Modified Davis grading; posterior pole photograph; acquired with a NIDEK AFC-230; nonmydriatic fundus photograph: 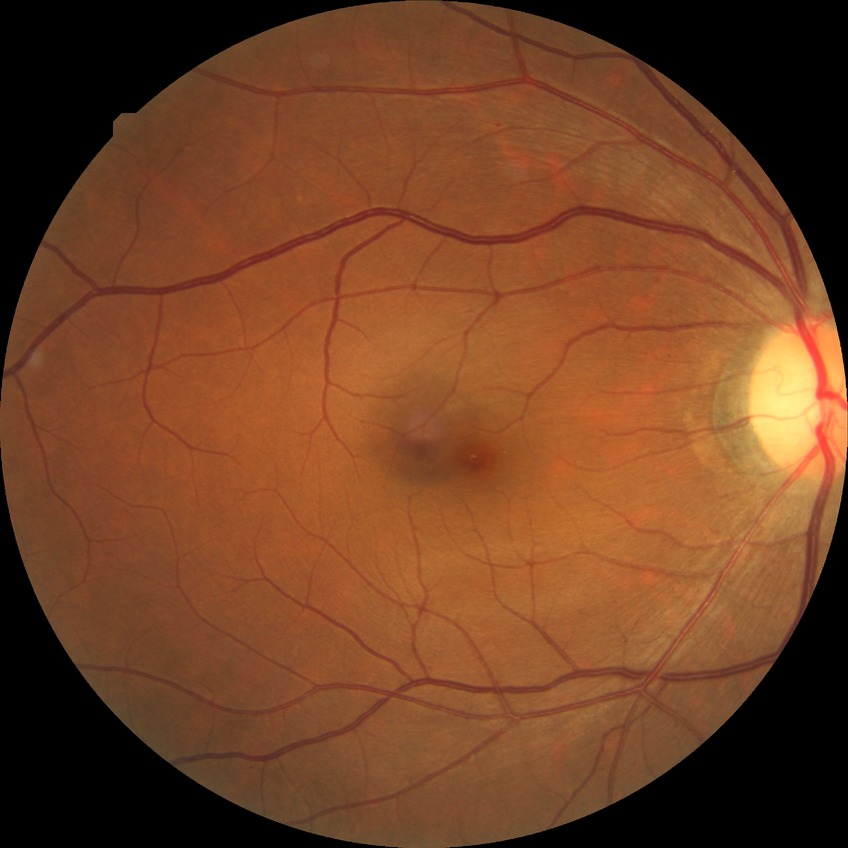 Diabetic retinopathy severity is no diabetic retinopathy.